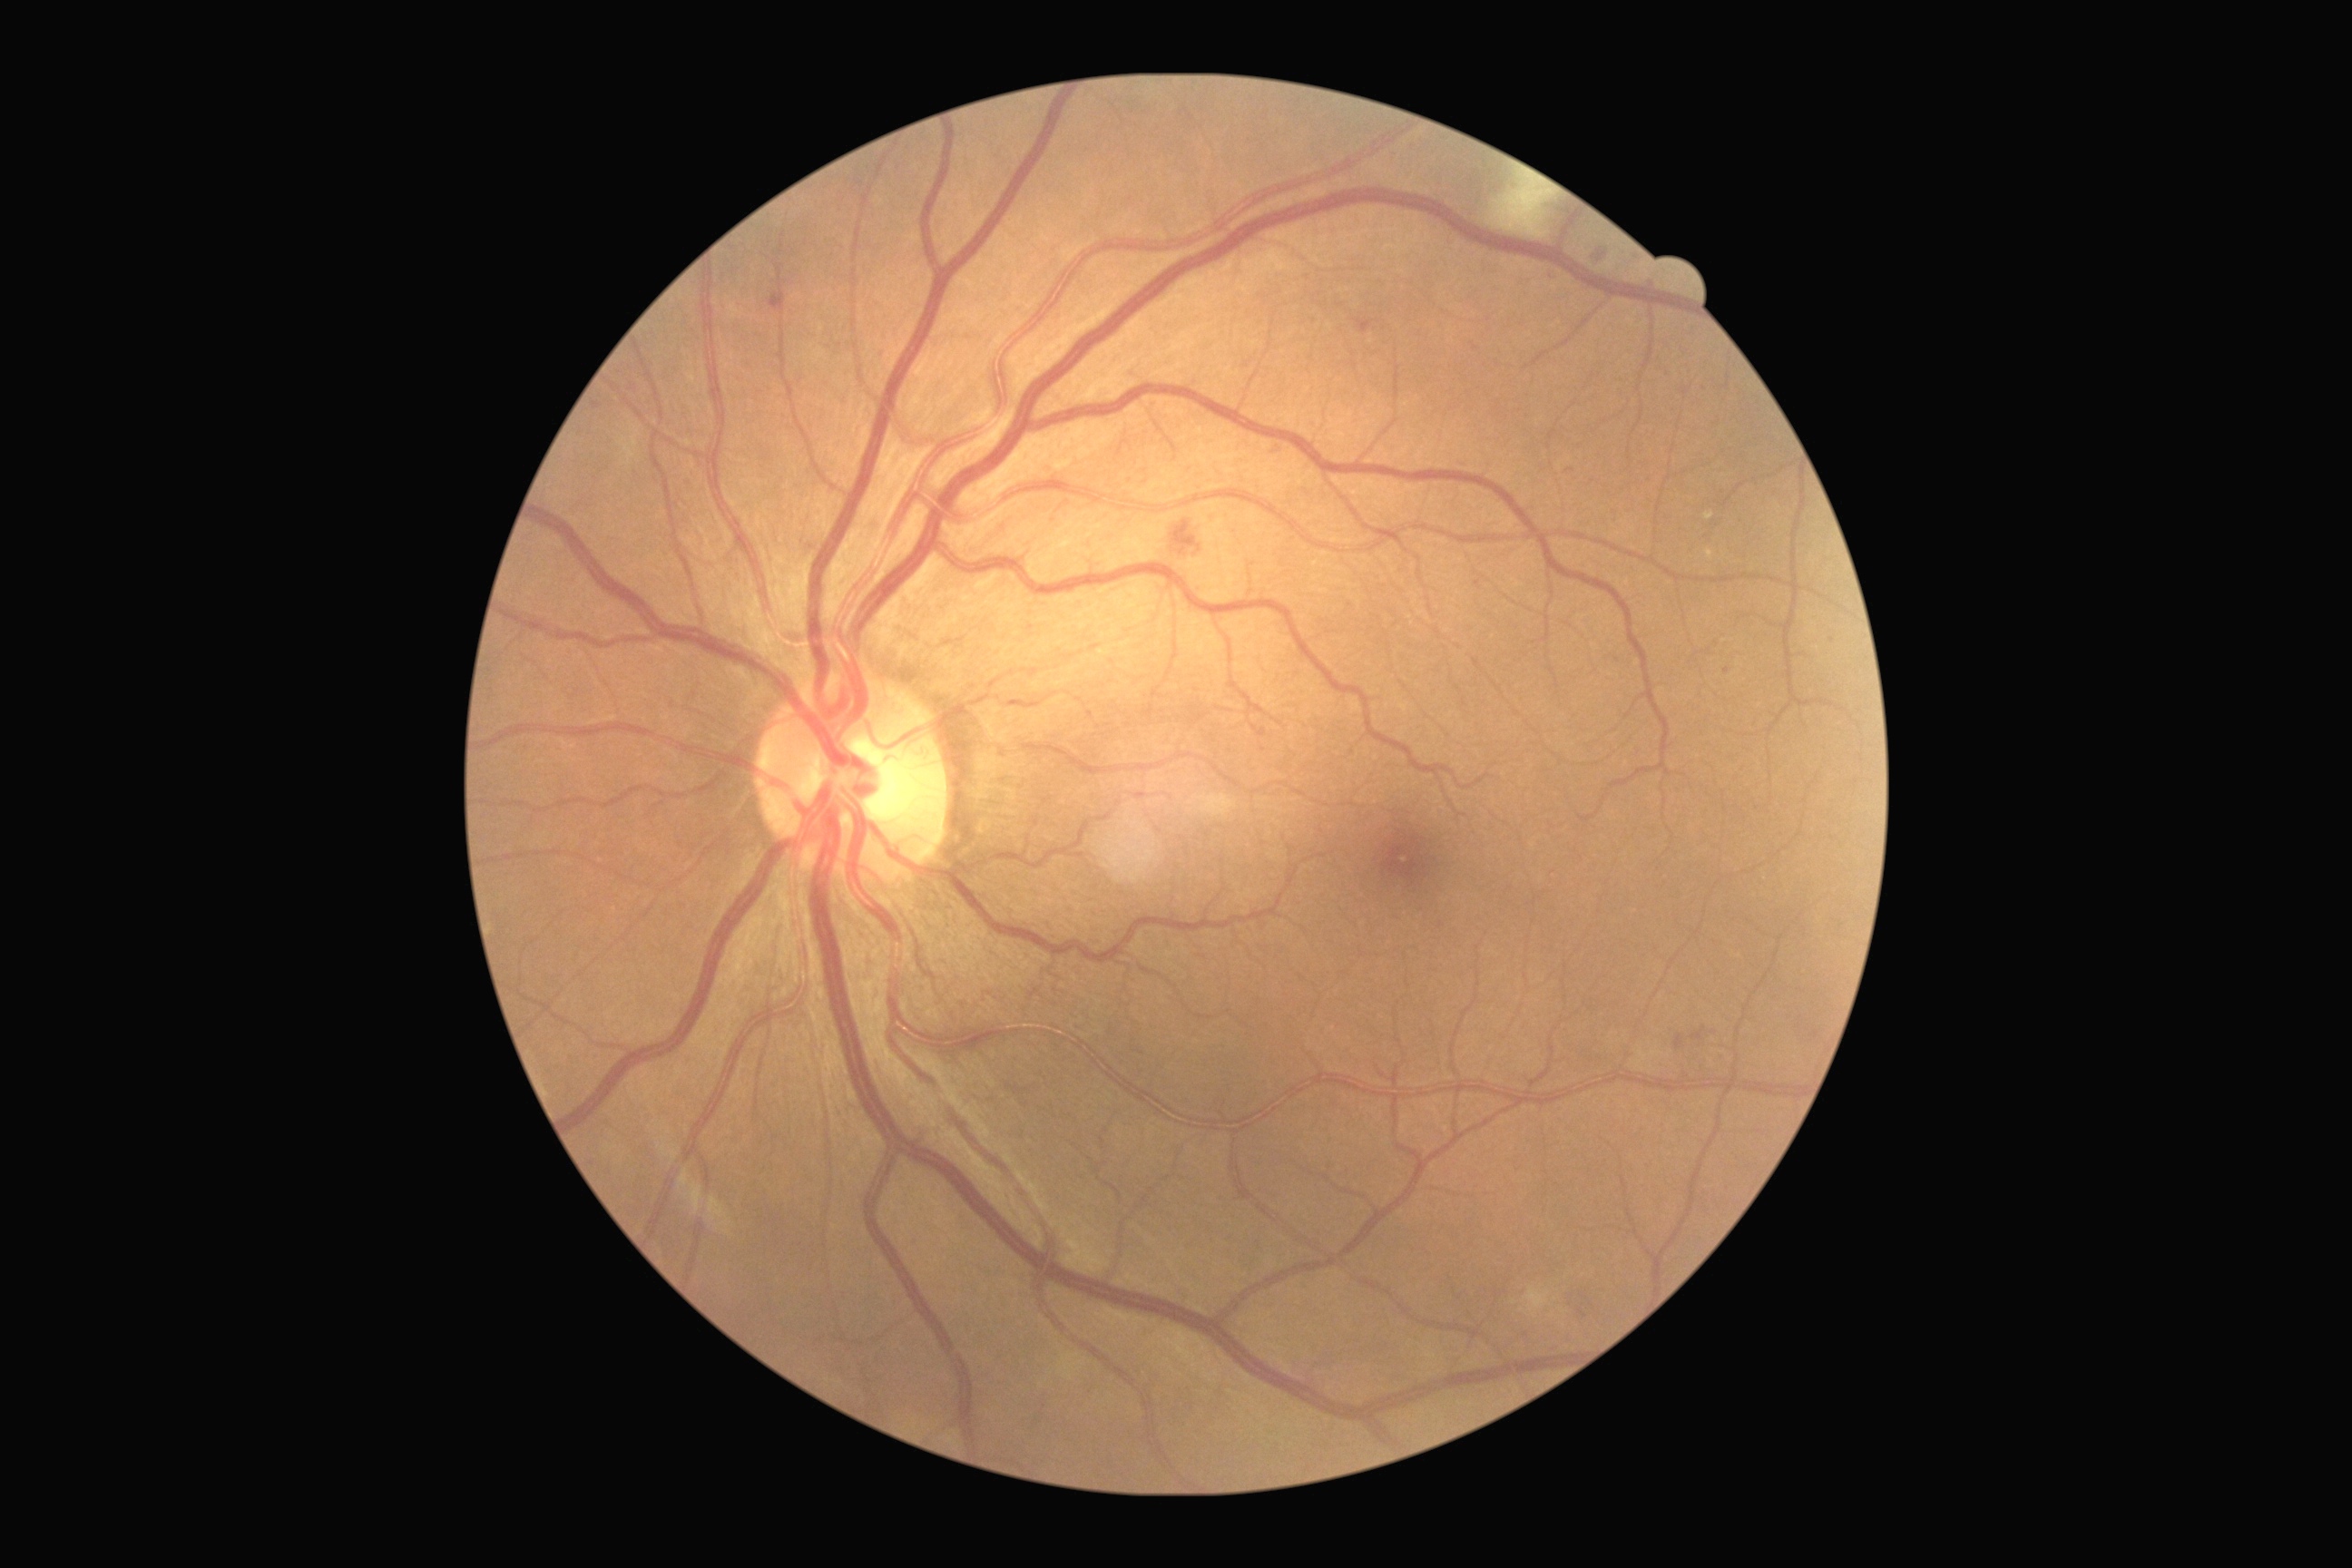 Findings:
• DR: grade 2 (moderate NPDR)
• DR class: non-proliferative diabetic retinopathy